848x848px — 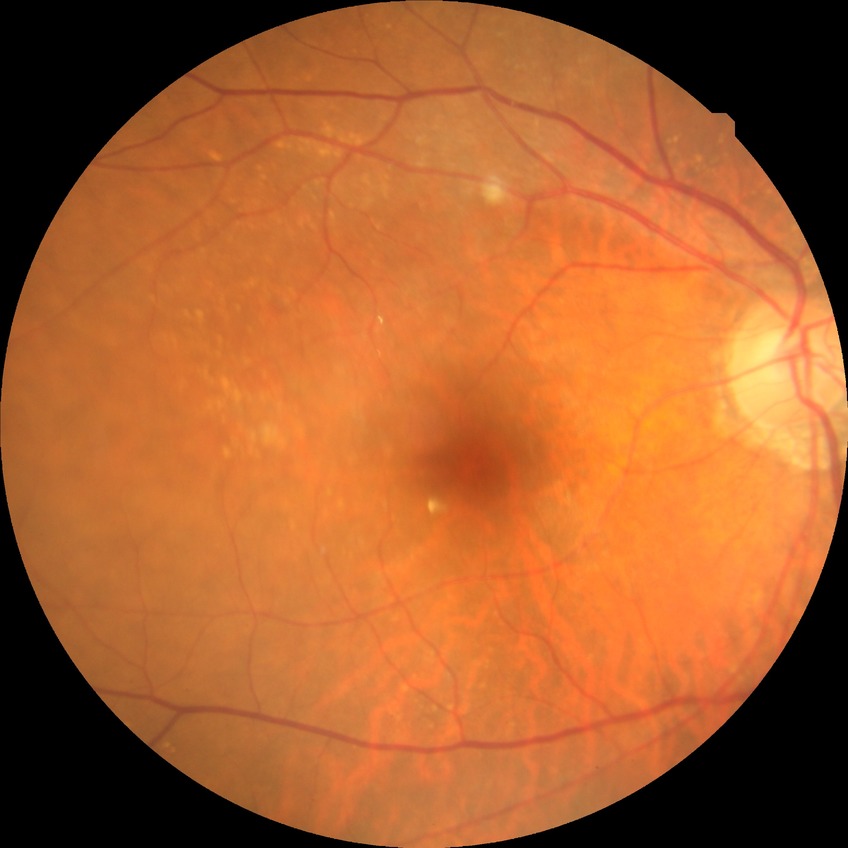

{"davis_grade": "NDR", "dr_impression": "no signs of DR"}